Color fundus photograph: 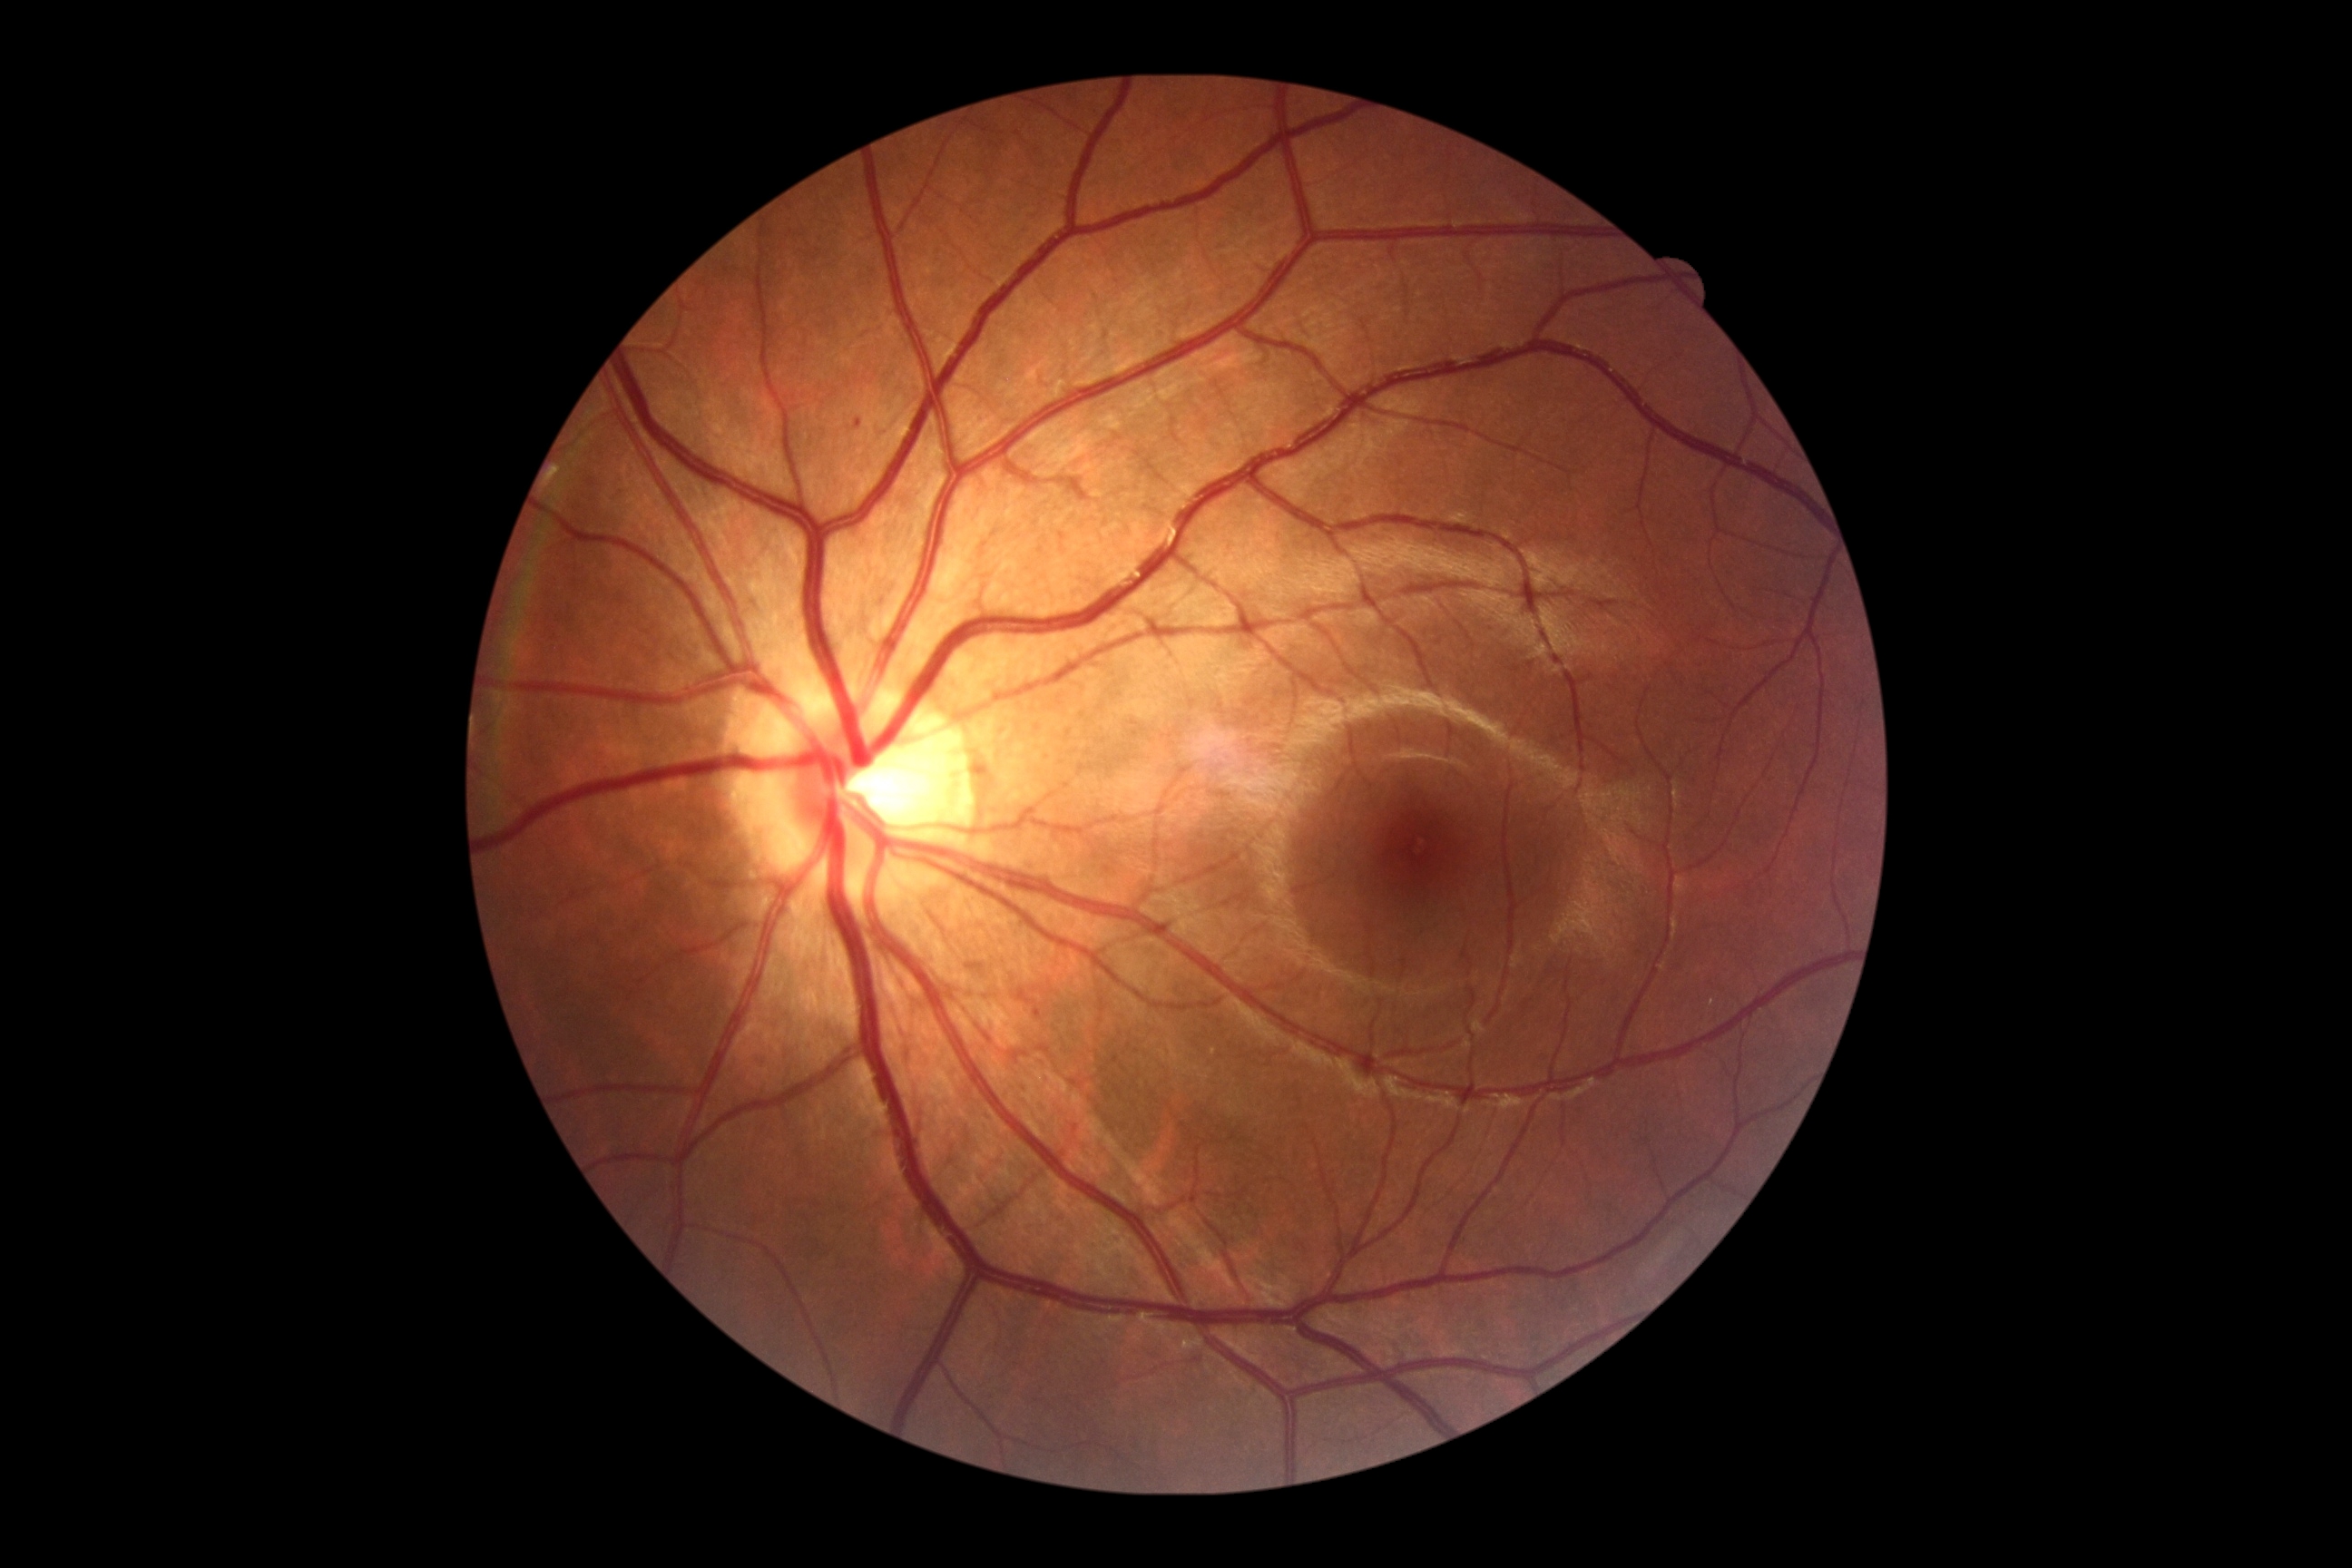

Diabetic retinopathy (DR) is grade 1 (mild NPDR).
No soft exudates (SEs) identified.
No hard exudates (EXs) identified.
No hemorrhages (HEs) identified.
Microaneurysms (MAs) at x1=854, y1=418, x2=861, y2=429; x1=1030, y1=1006, x2=1041, y2=1014.